Acquired with a Remidio smartphone fundus camera: 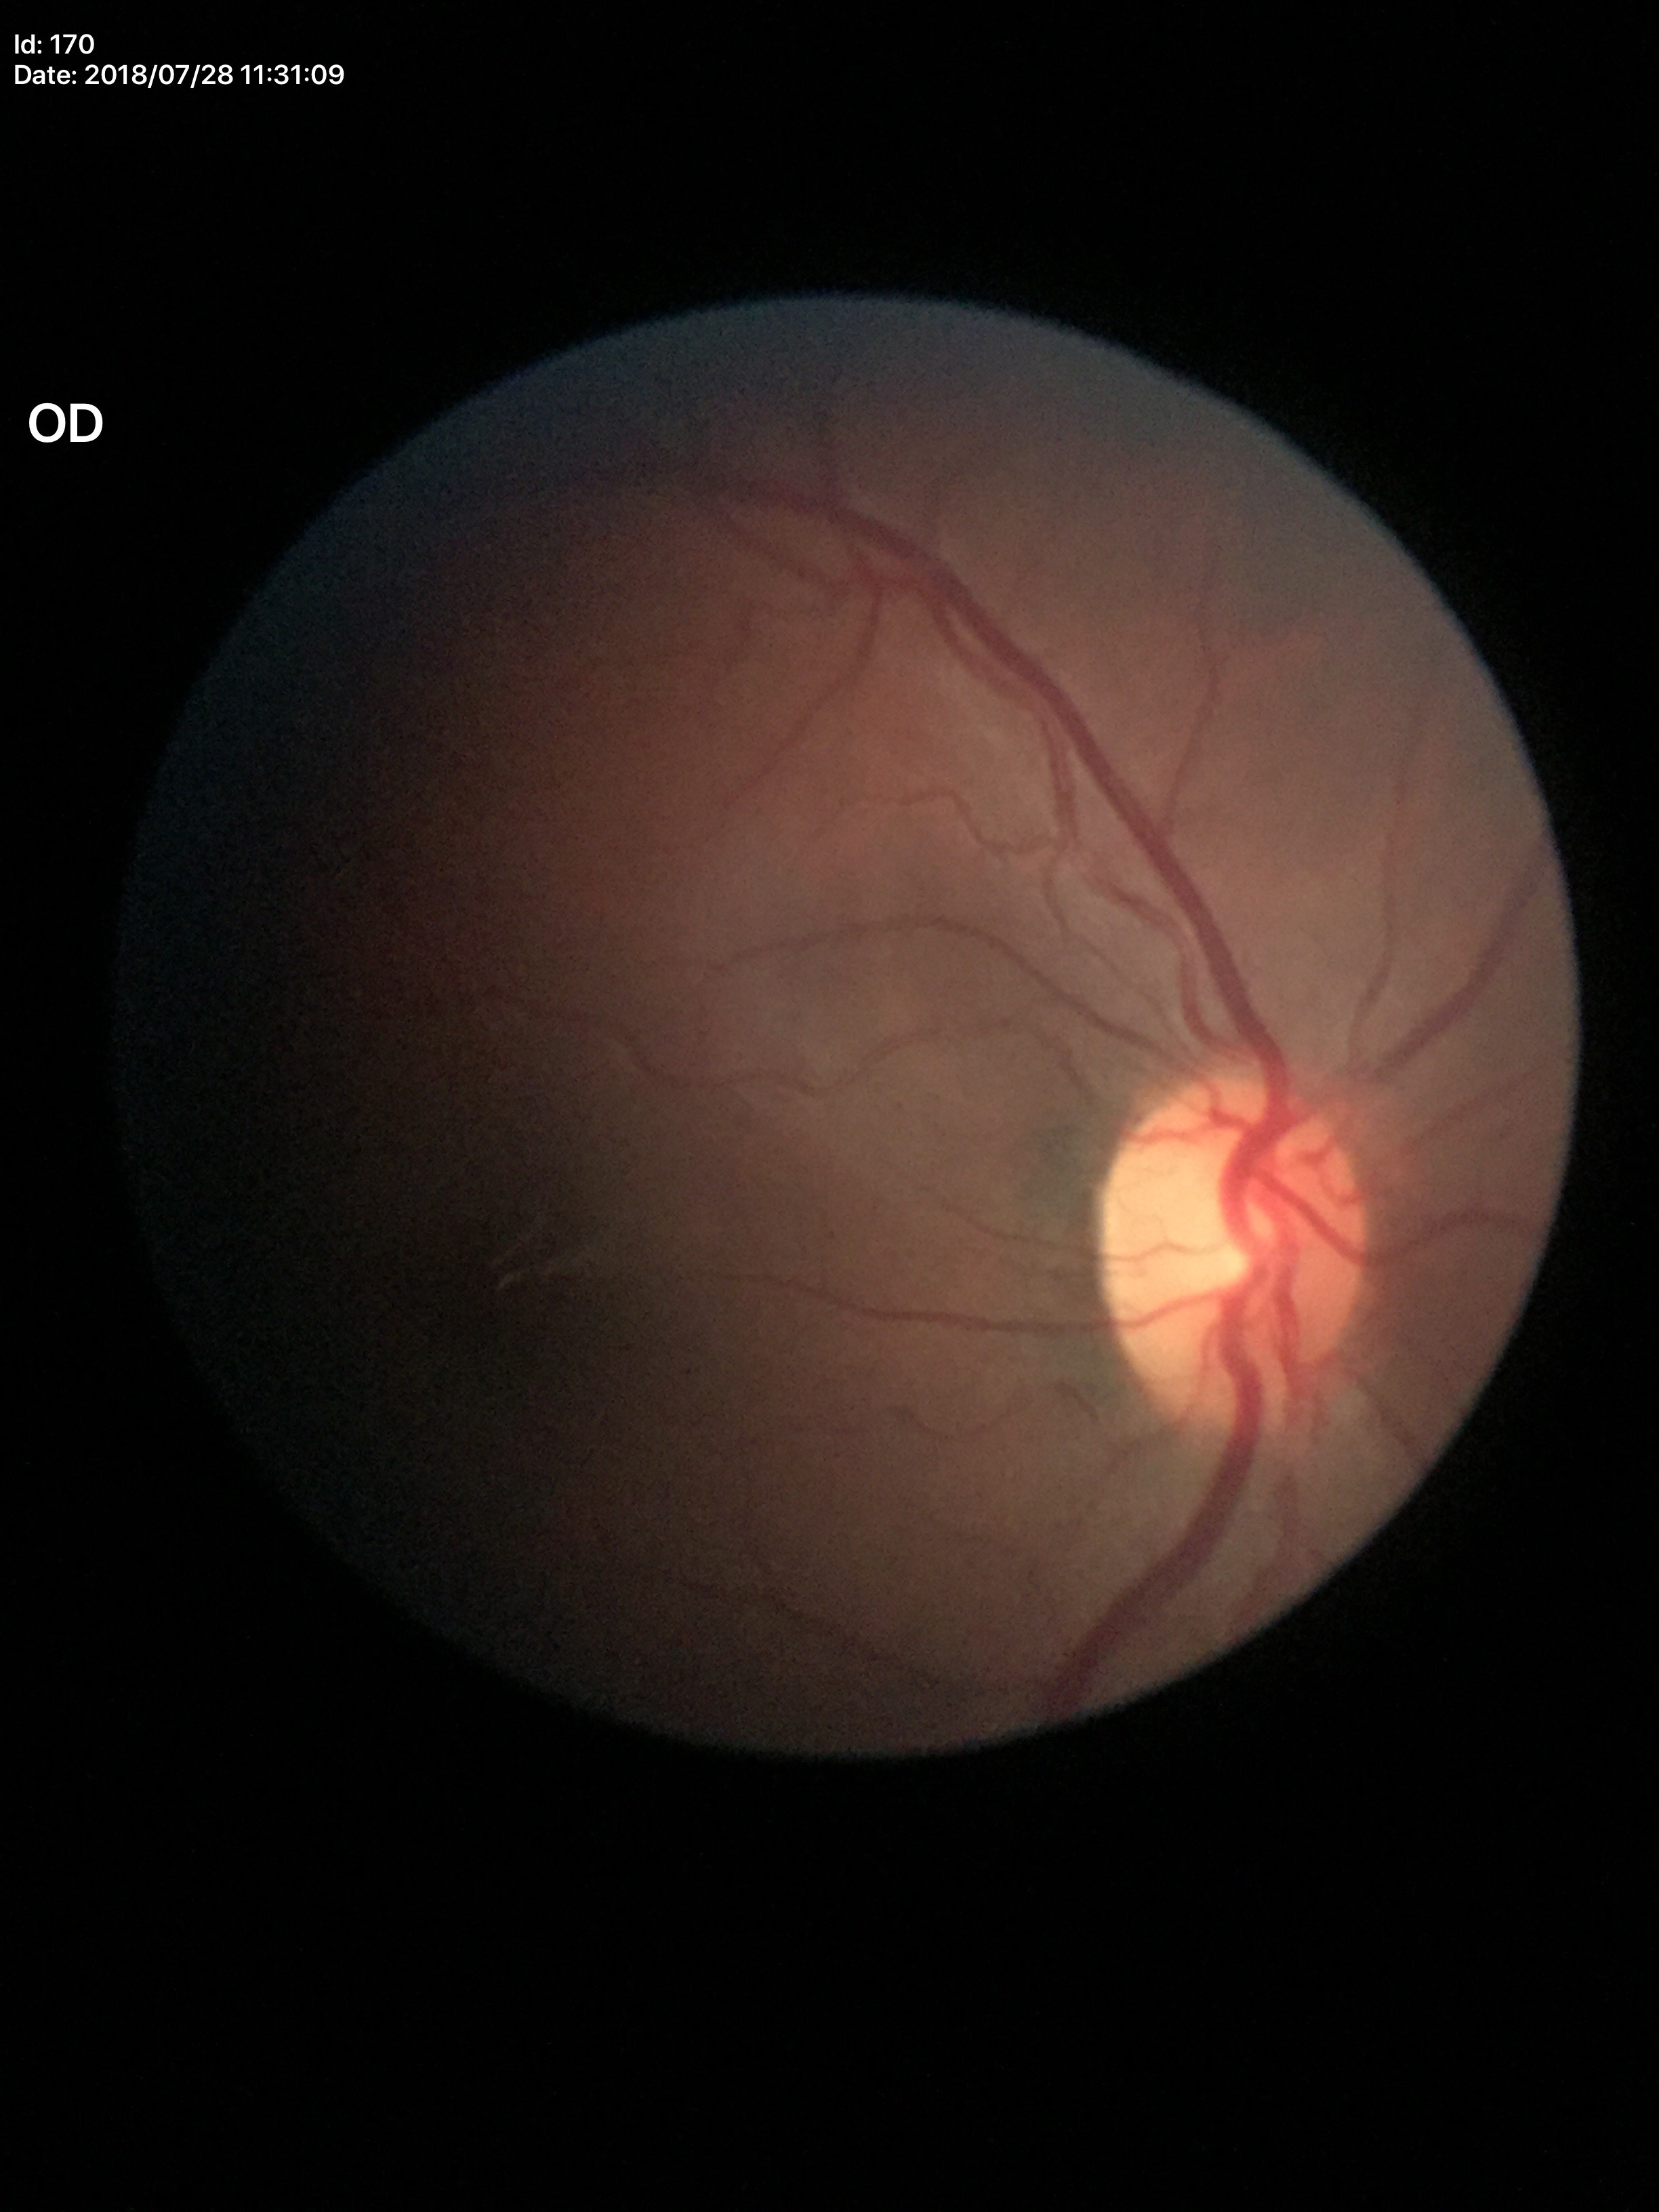

Glaucoma assessment: suspect. Vertical CDR: 0.55. Horizontal C/D ratio of 0.53.